848 x 848 pixels; acquired with a NIDEK AFC-230; fundus photo; no pharmacologic dilation — 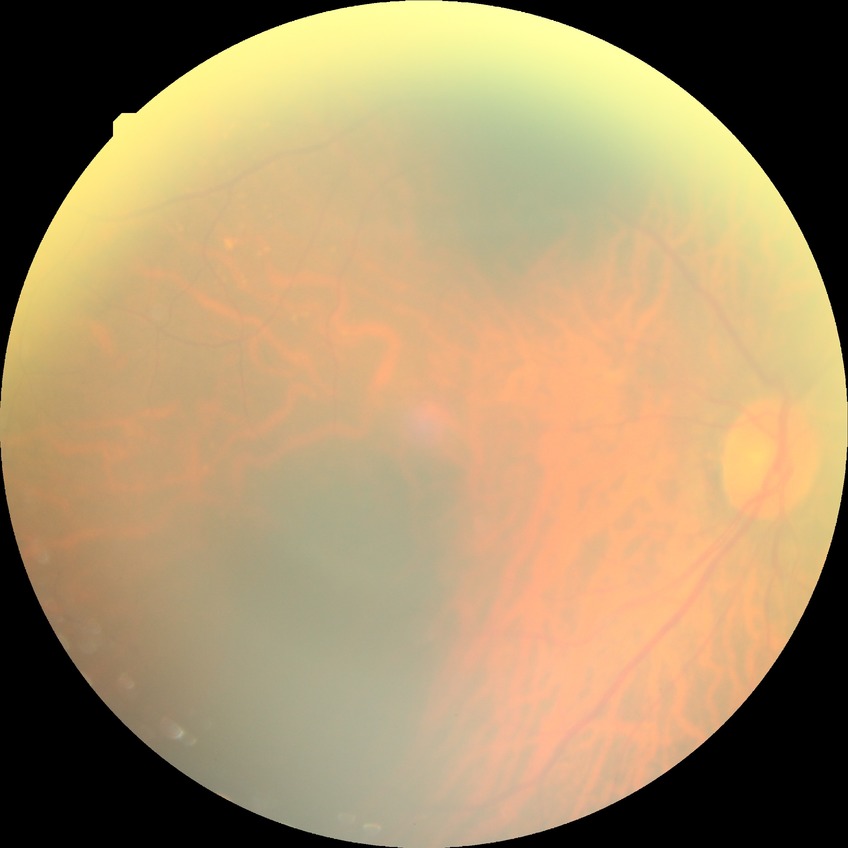

* retinopathy stage — simple diabetic retinopathy